Infant wide-field retinal image.
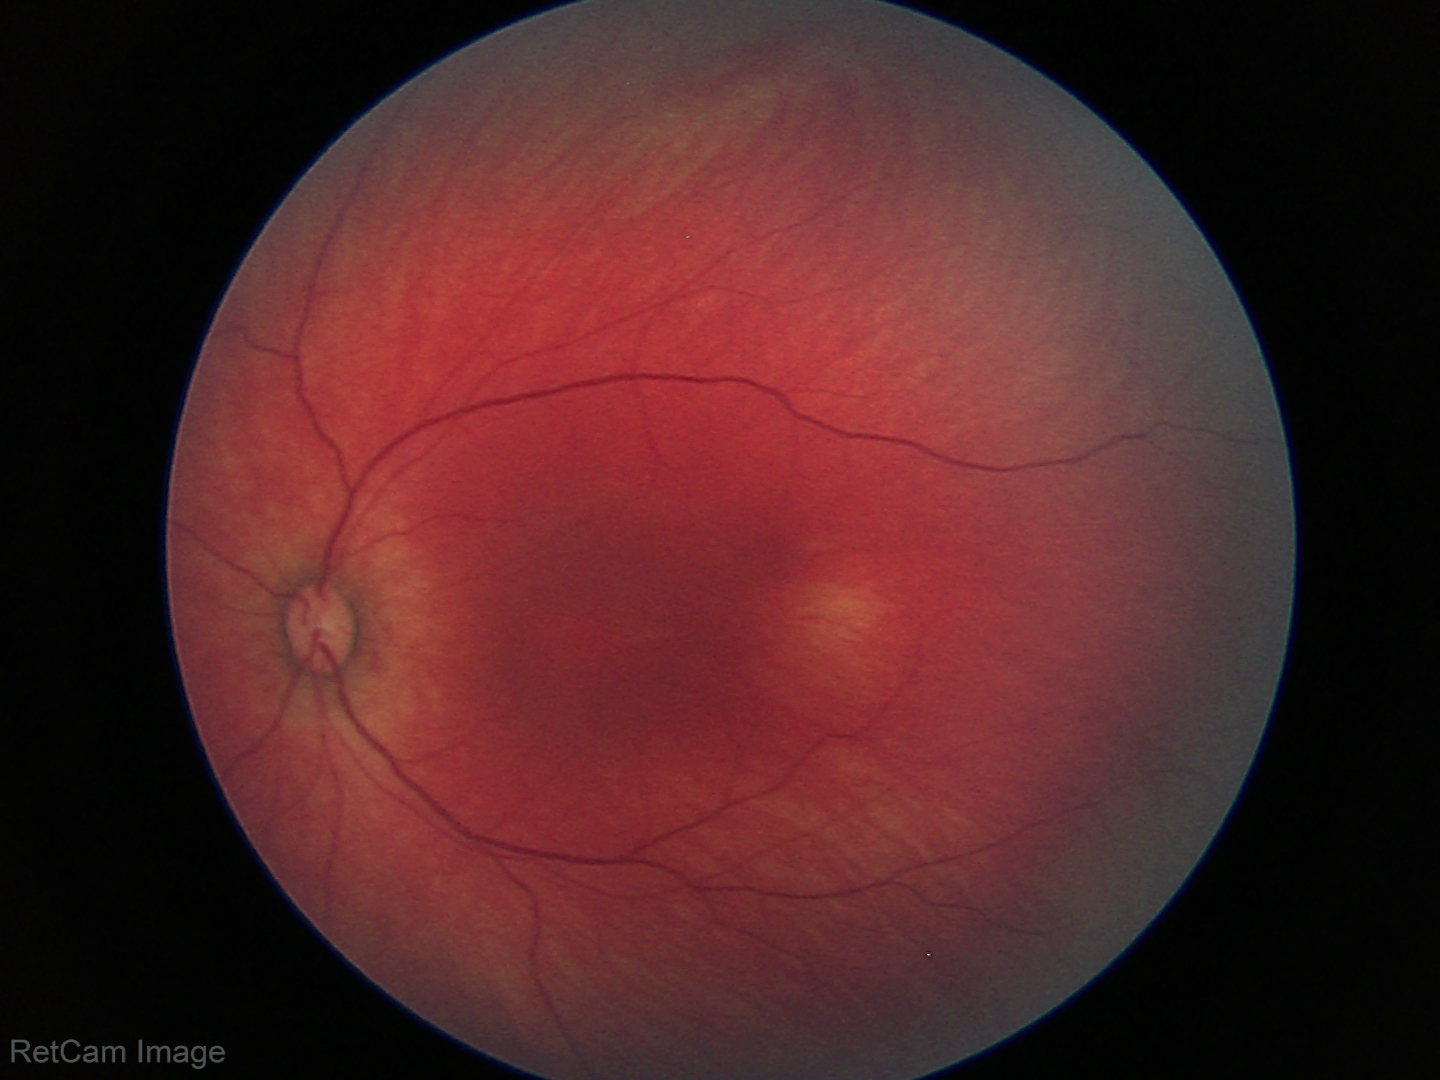

Screening examination diagnosed as physiological.